2212 by 1659 pixels. FOV: 45 degrees:
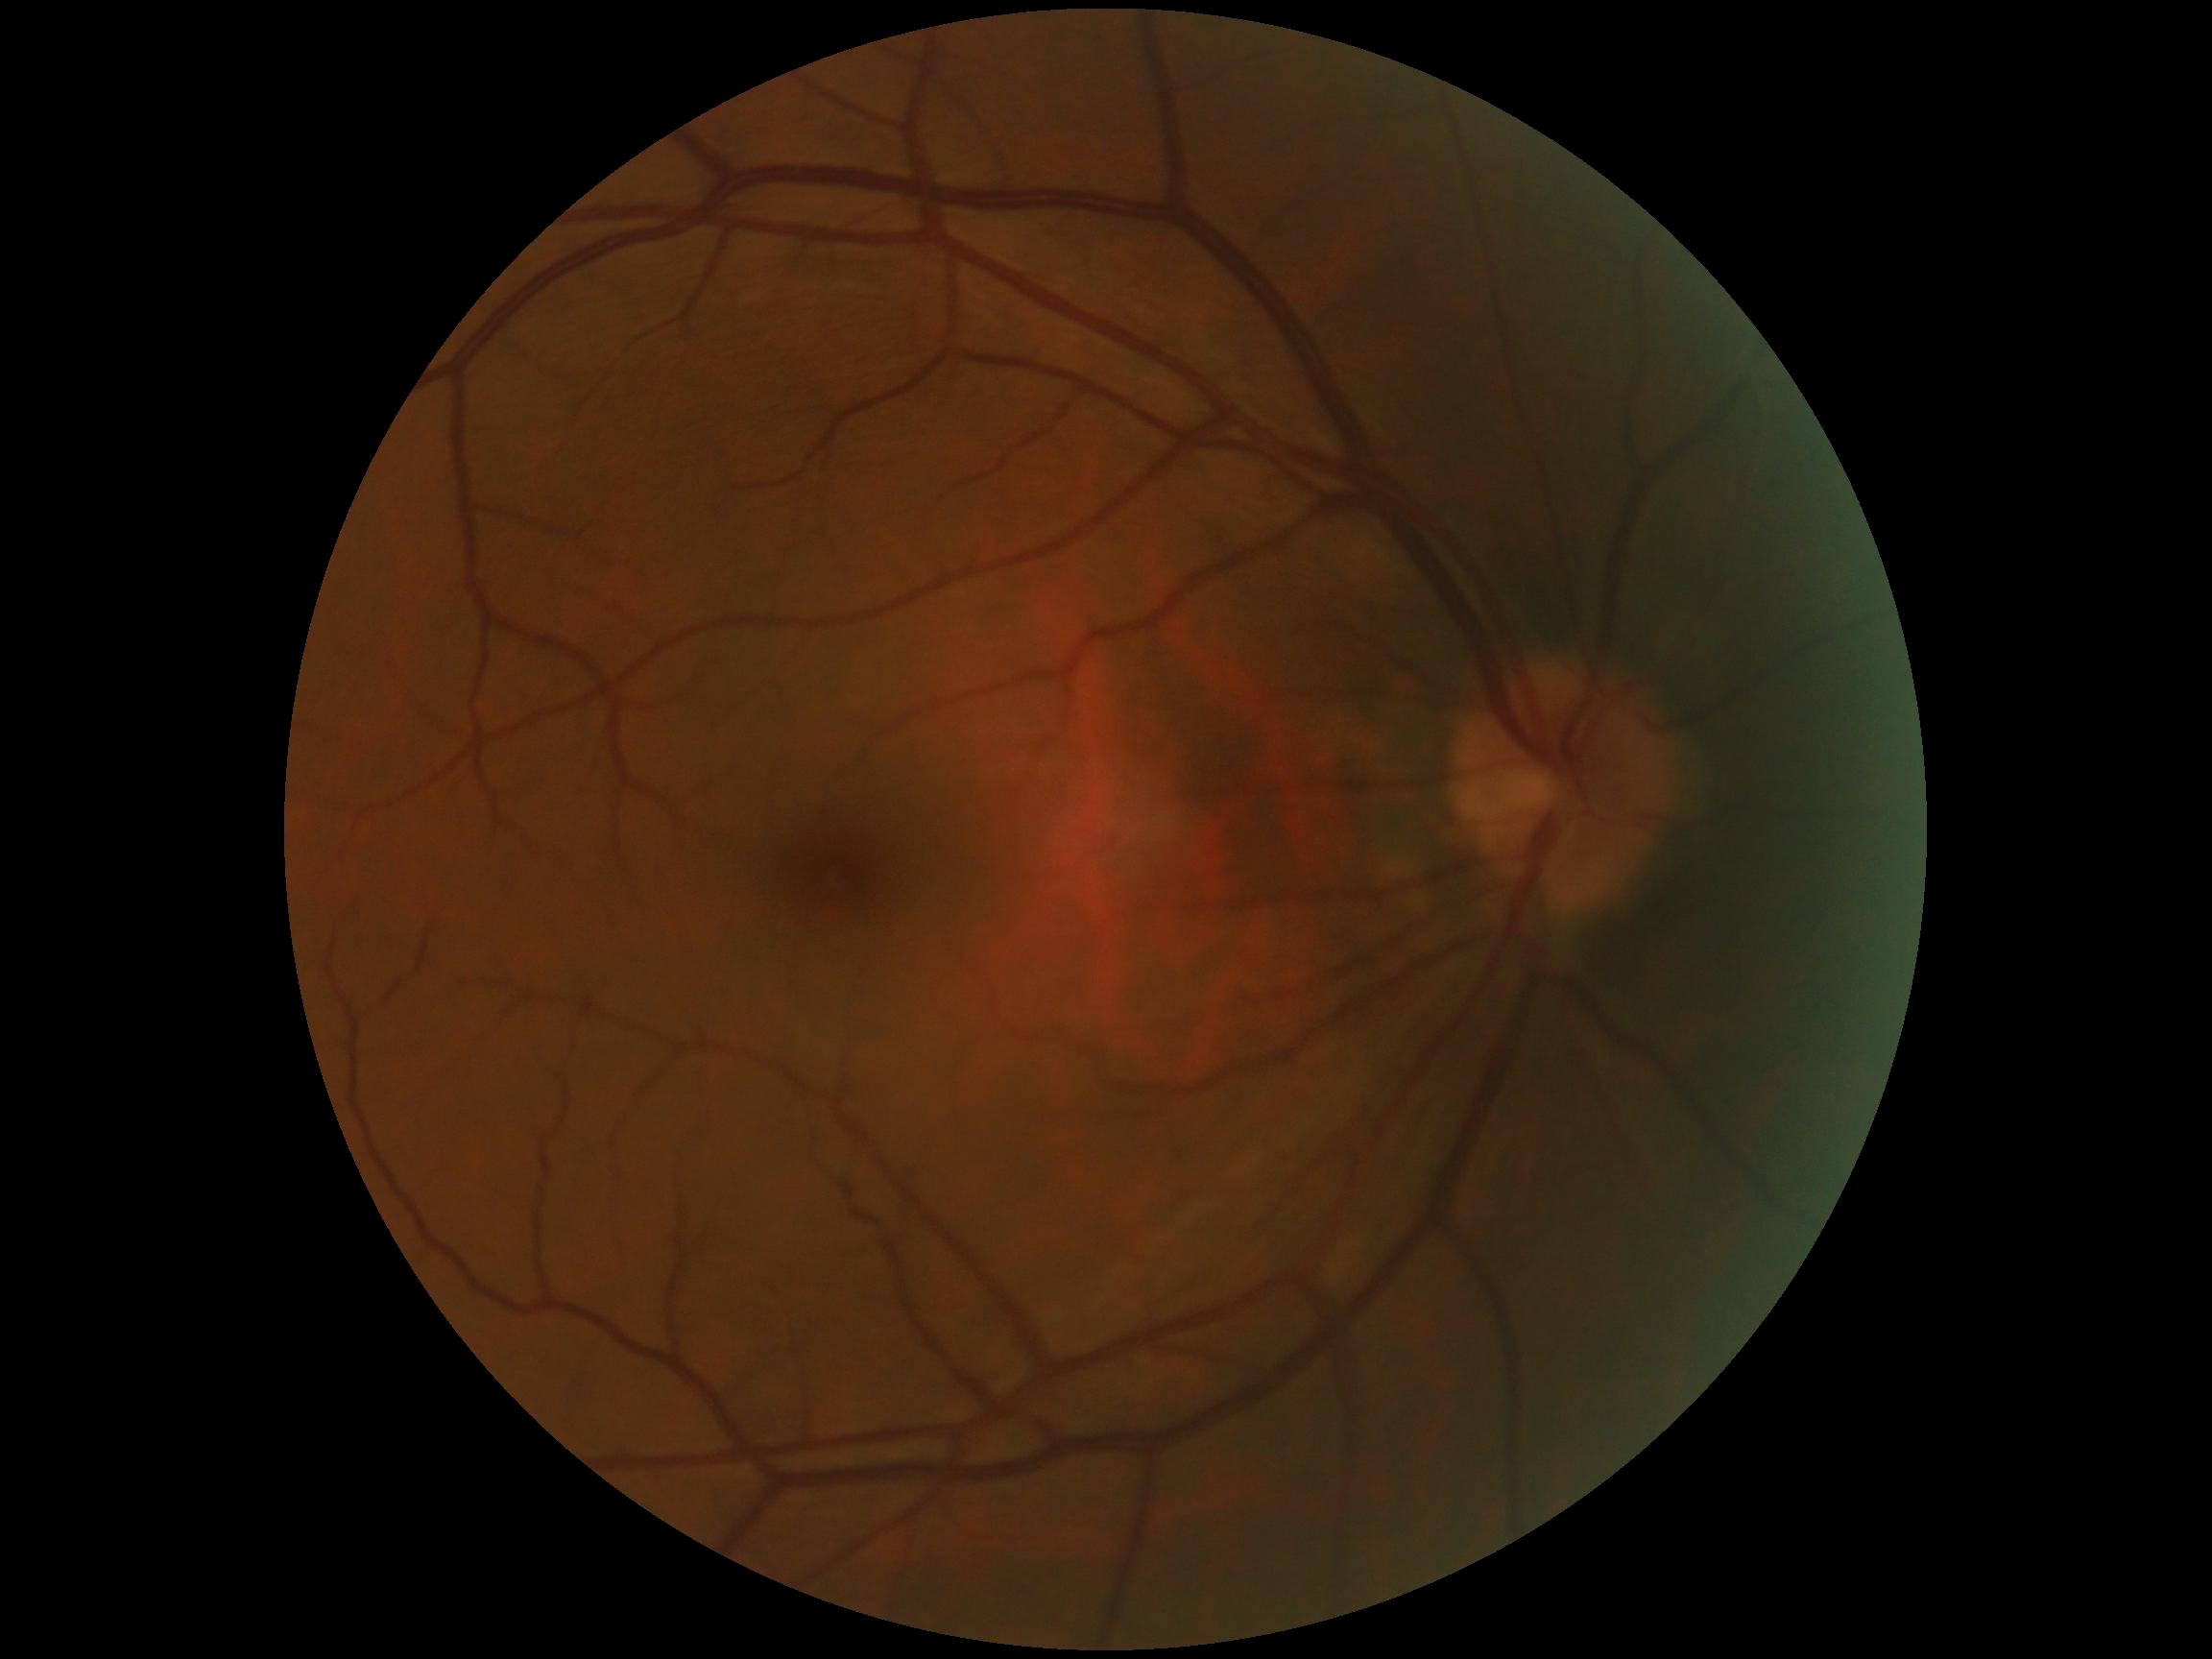

retinopathy grade@0, DR impression@negative for DR.